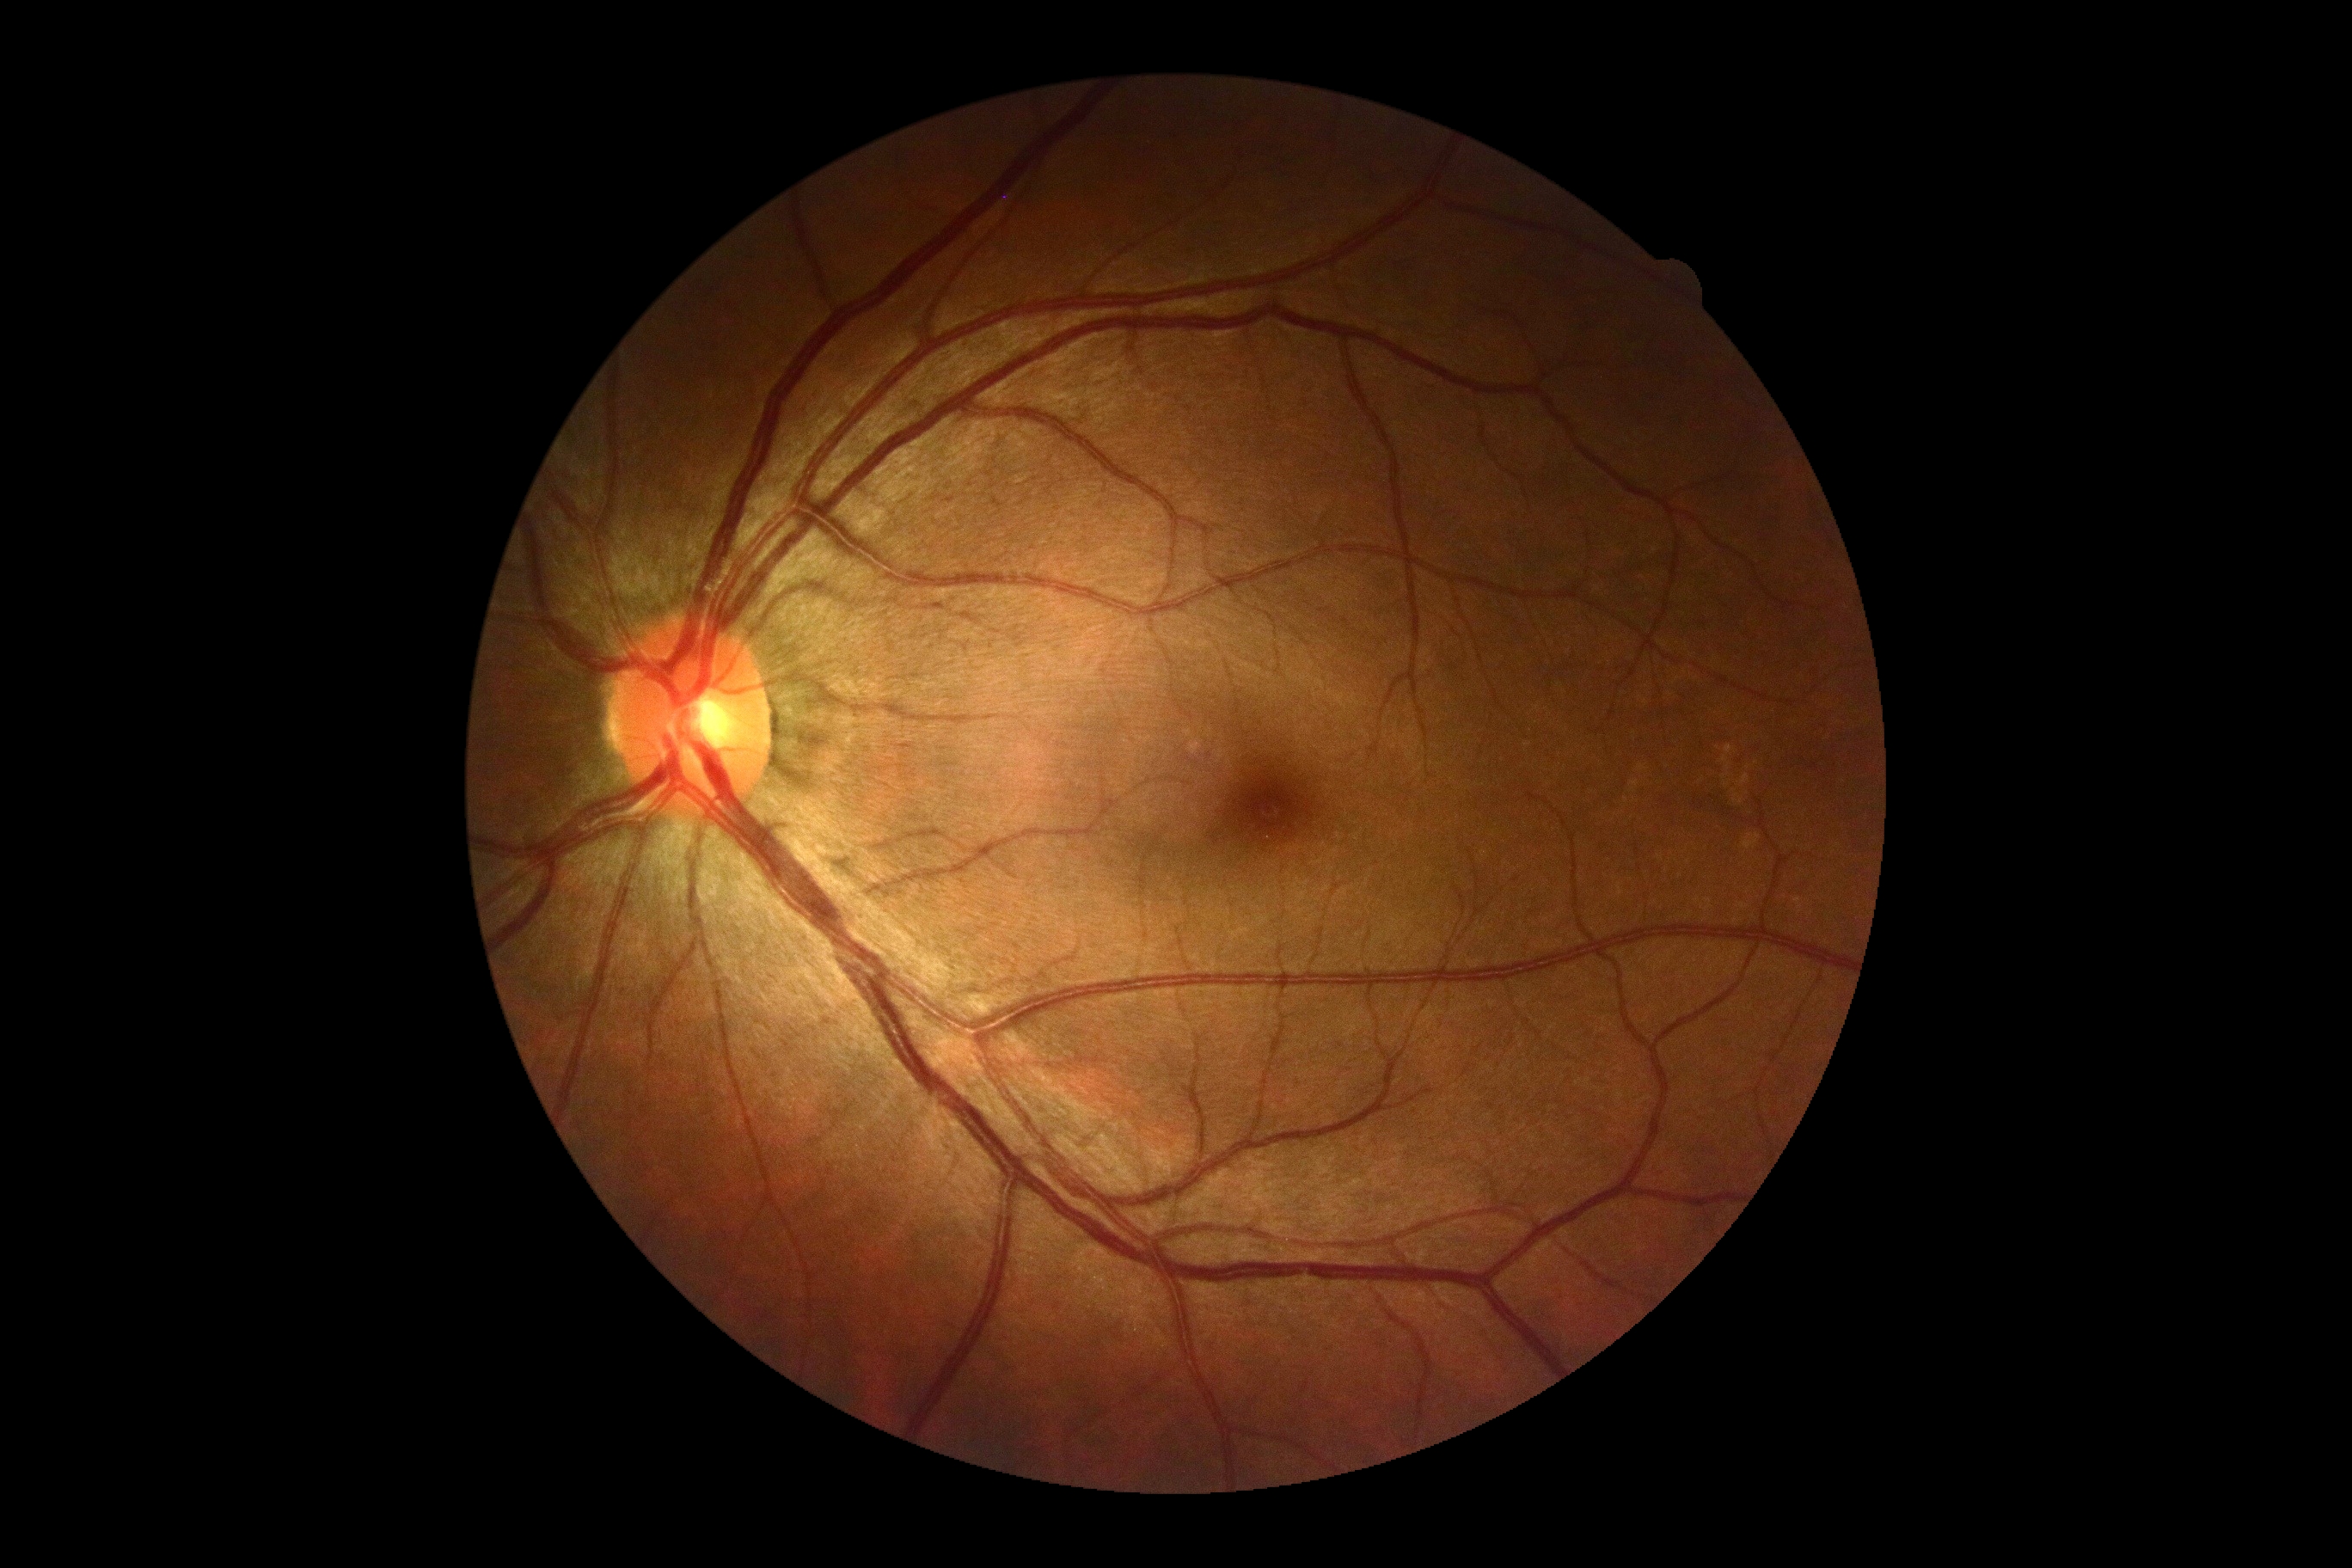 diabetic retinopathy severity=grade 0 — no visible signs of diabetic retinopathy; DR impression=no signs of DR.